Posterior pole color fundus photograph. Image size 848x848. 45° FOV:
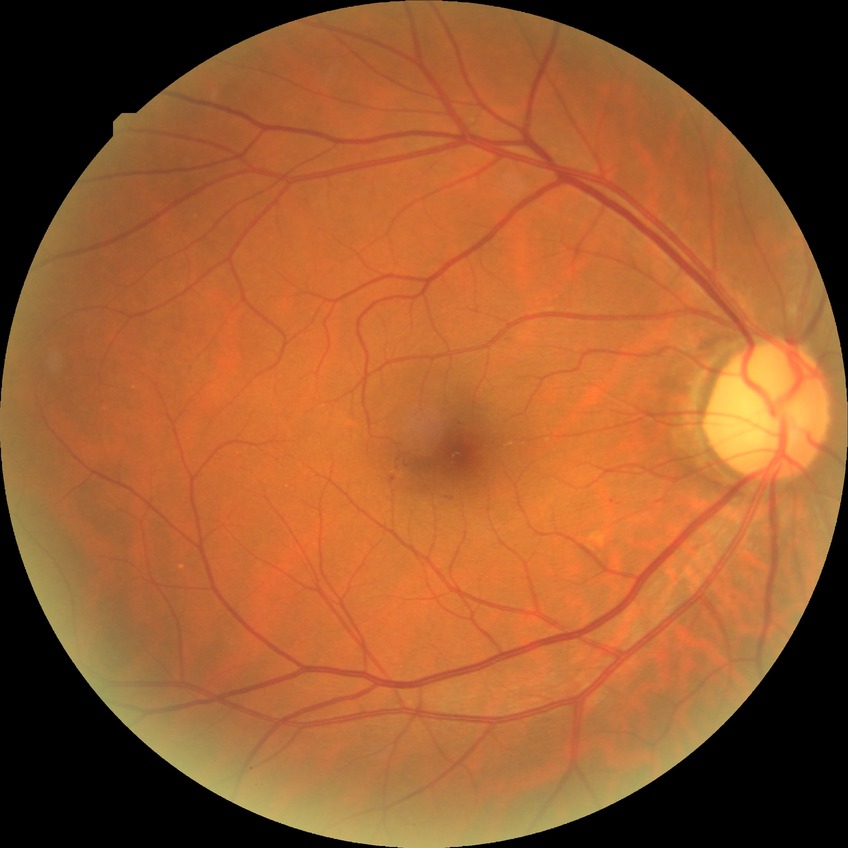
Diabetic retinopathy severity: simple diabetic retinopathy.
Disease class: non-proliferative diabetic retinopathy.